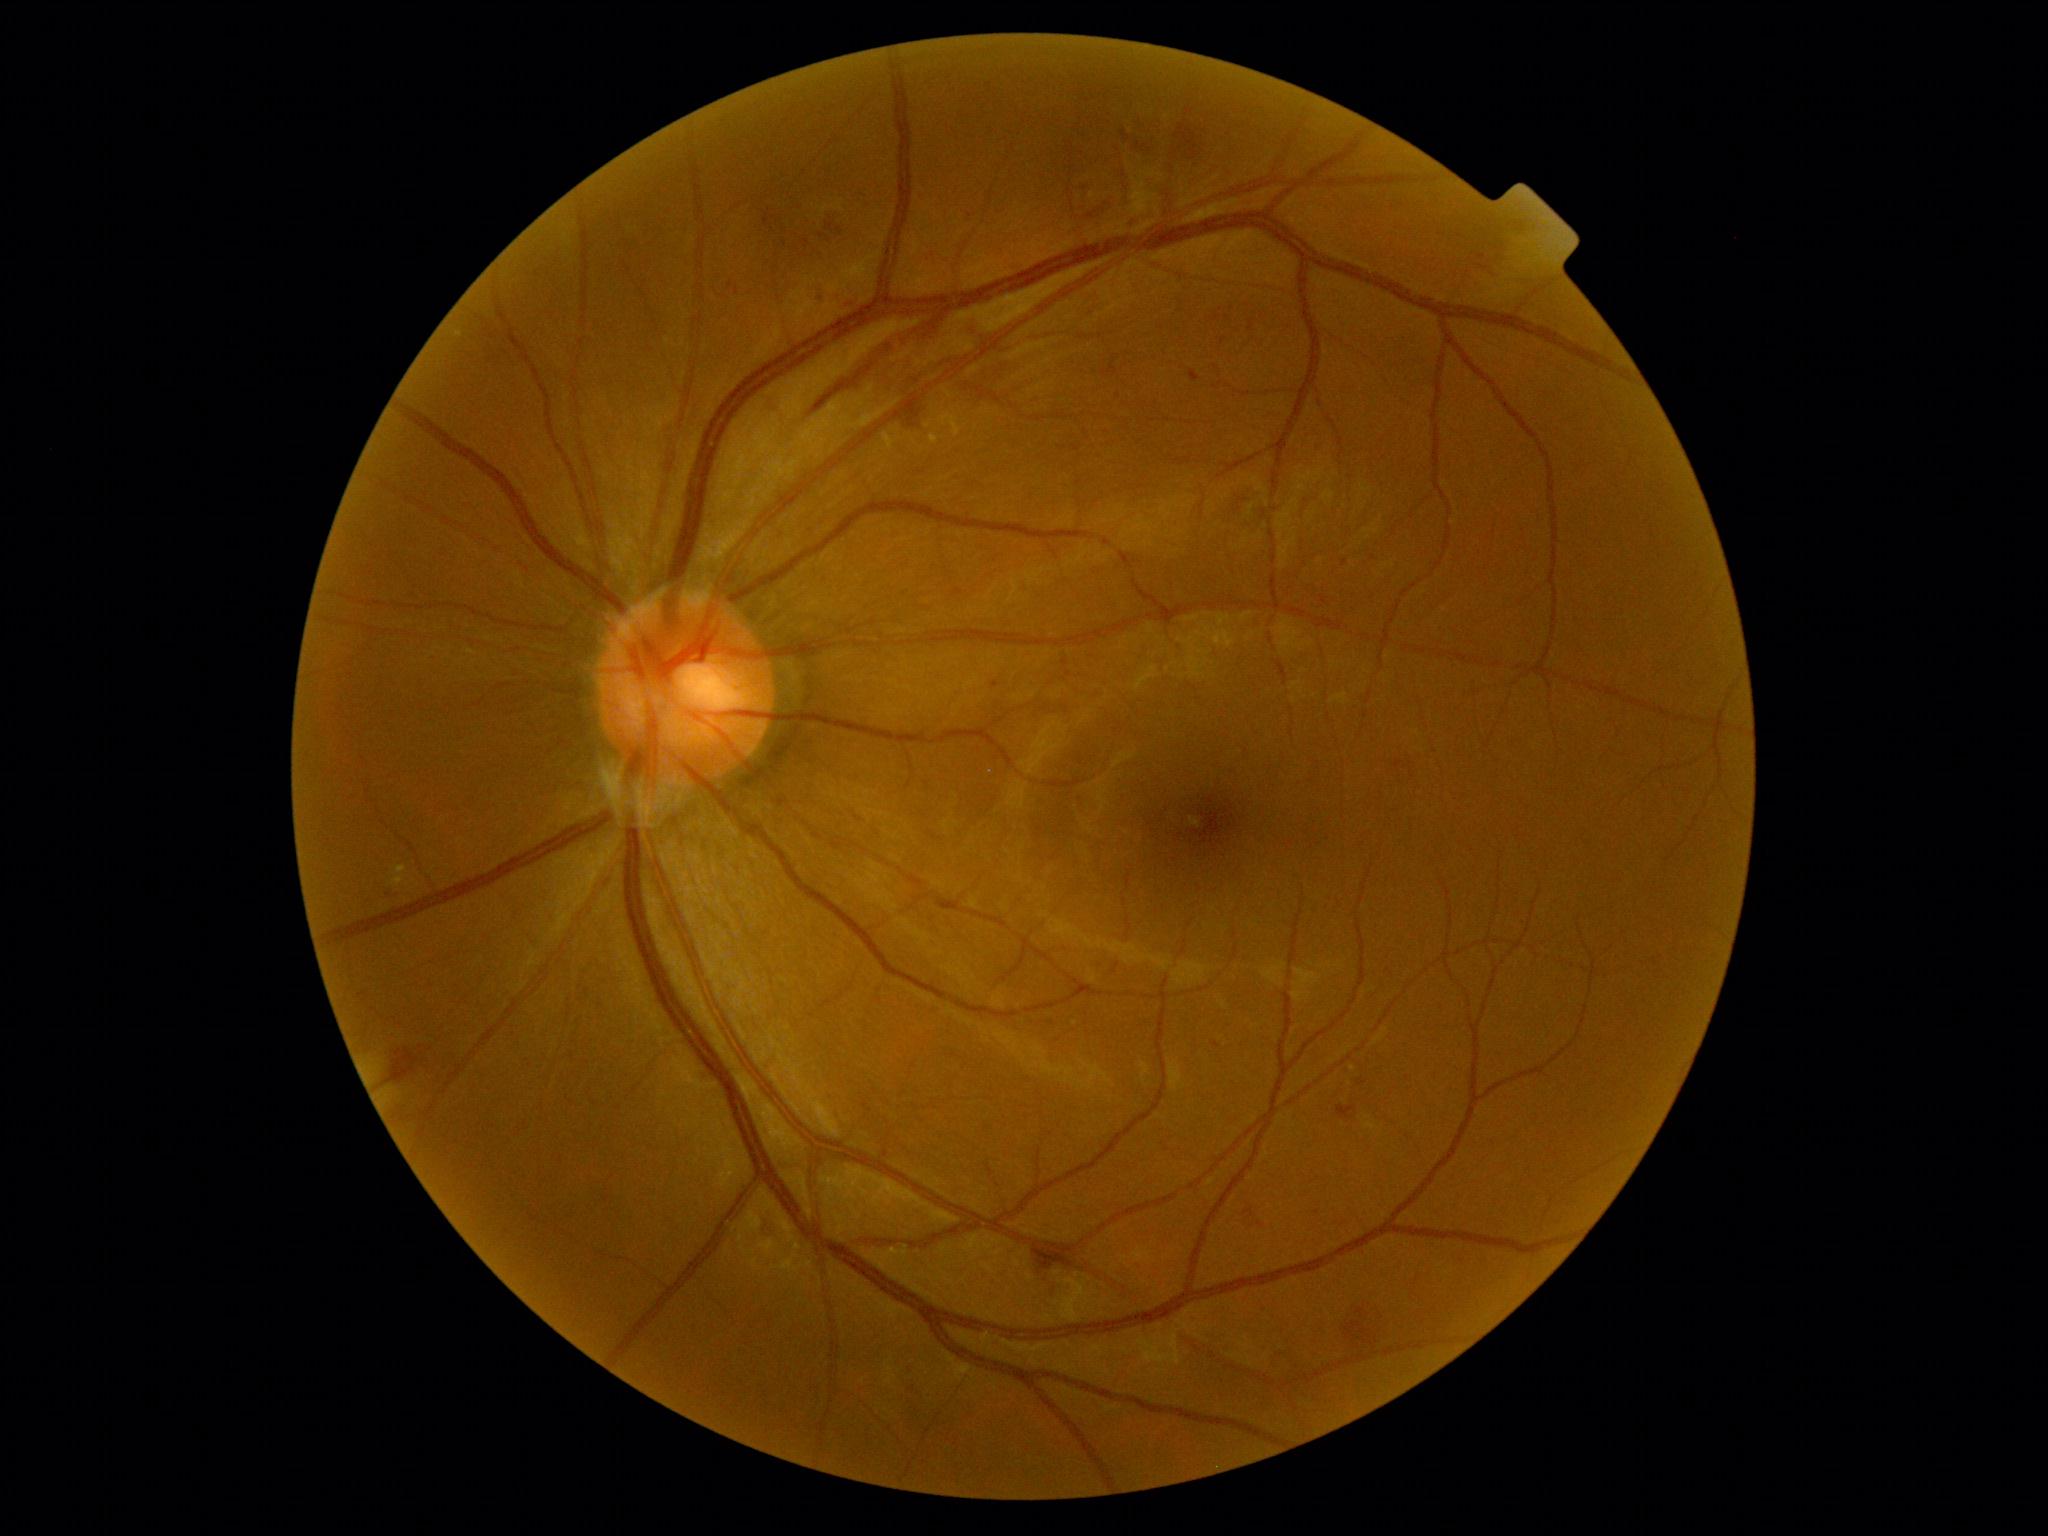 Diabetic retinopathy severity is grade 2 (moderate NPDR)
Selected lesions:
Microaneurysms (small, approximate centers) near (1345,563); (1217,1045); (995,685)
hemorrhages (continued) = bbox=(764, 215, 769, 226); bbox=(818, 292, 822, 304); bbox=(827, 223, 834, 232); bbox=(1030, 1249, 1072, 1269); bbox=(818, 314, 943, 417); bbox=(1345, 1322, 1374, 1346); bbox=(904, 405, 921, 425); bbox=(833, 301, 853, 311); bbox=(390, 1048, 420, 1082); bbox=(1357, 1307, 1365, 1317)
Hemorrhages (small, approximate centers) near (807,243); (1196,120)
soft exudates = not present
hard exudates = bbox=(394, 873, 401, 884); bbox=(930, 434, 940, 445); bbox=(394, 863, 401, 871)